CFP.
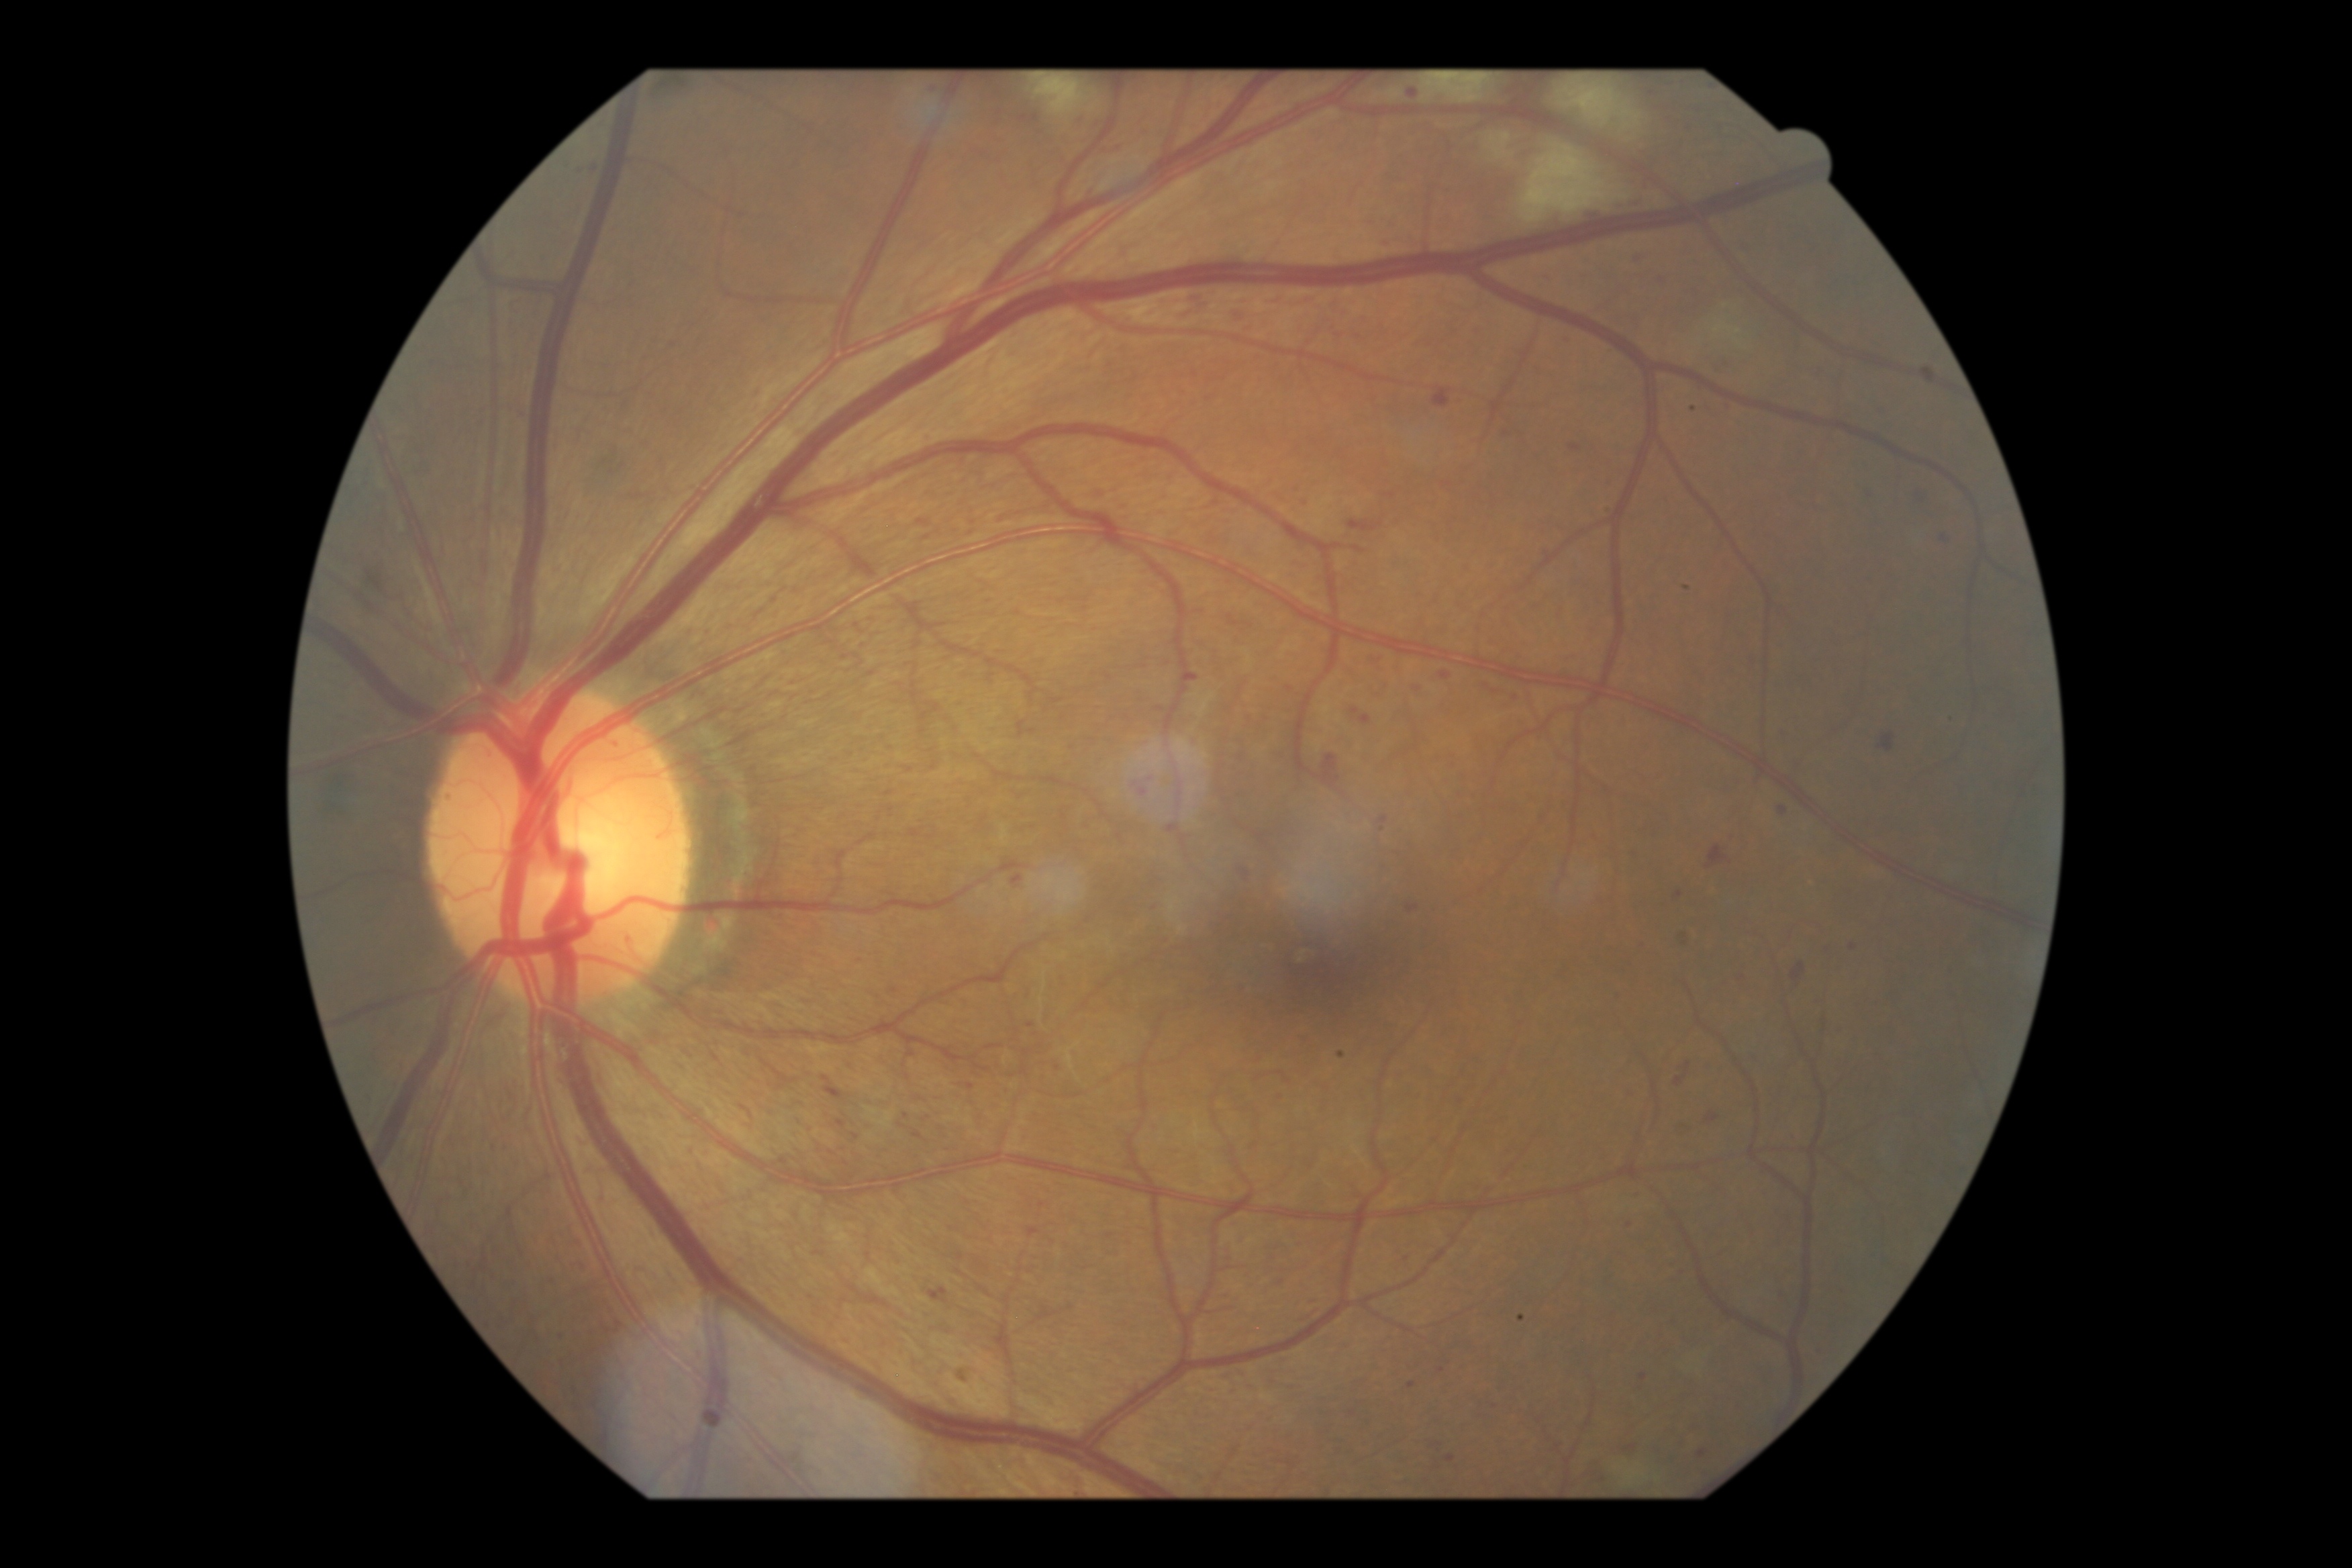 DR grade: 2 (moderate NPDR).